Modified Davis grading: 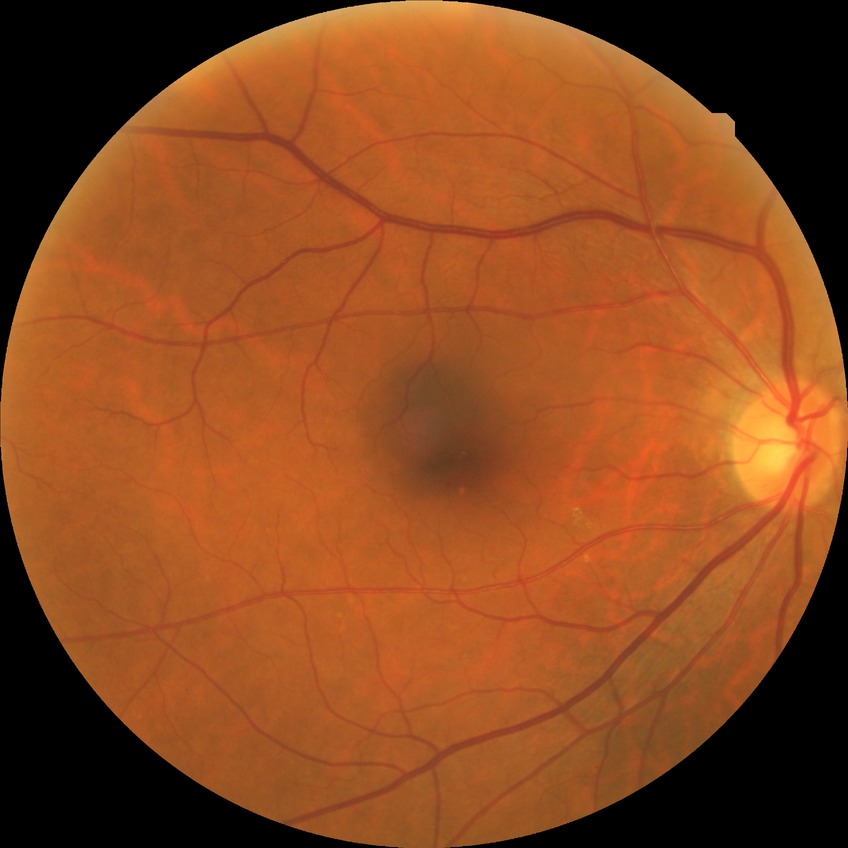 Diabetic retinopathy stage is no diabetic retinopathy.